CFP · 45-degree field of view · 2048x1536px
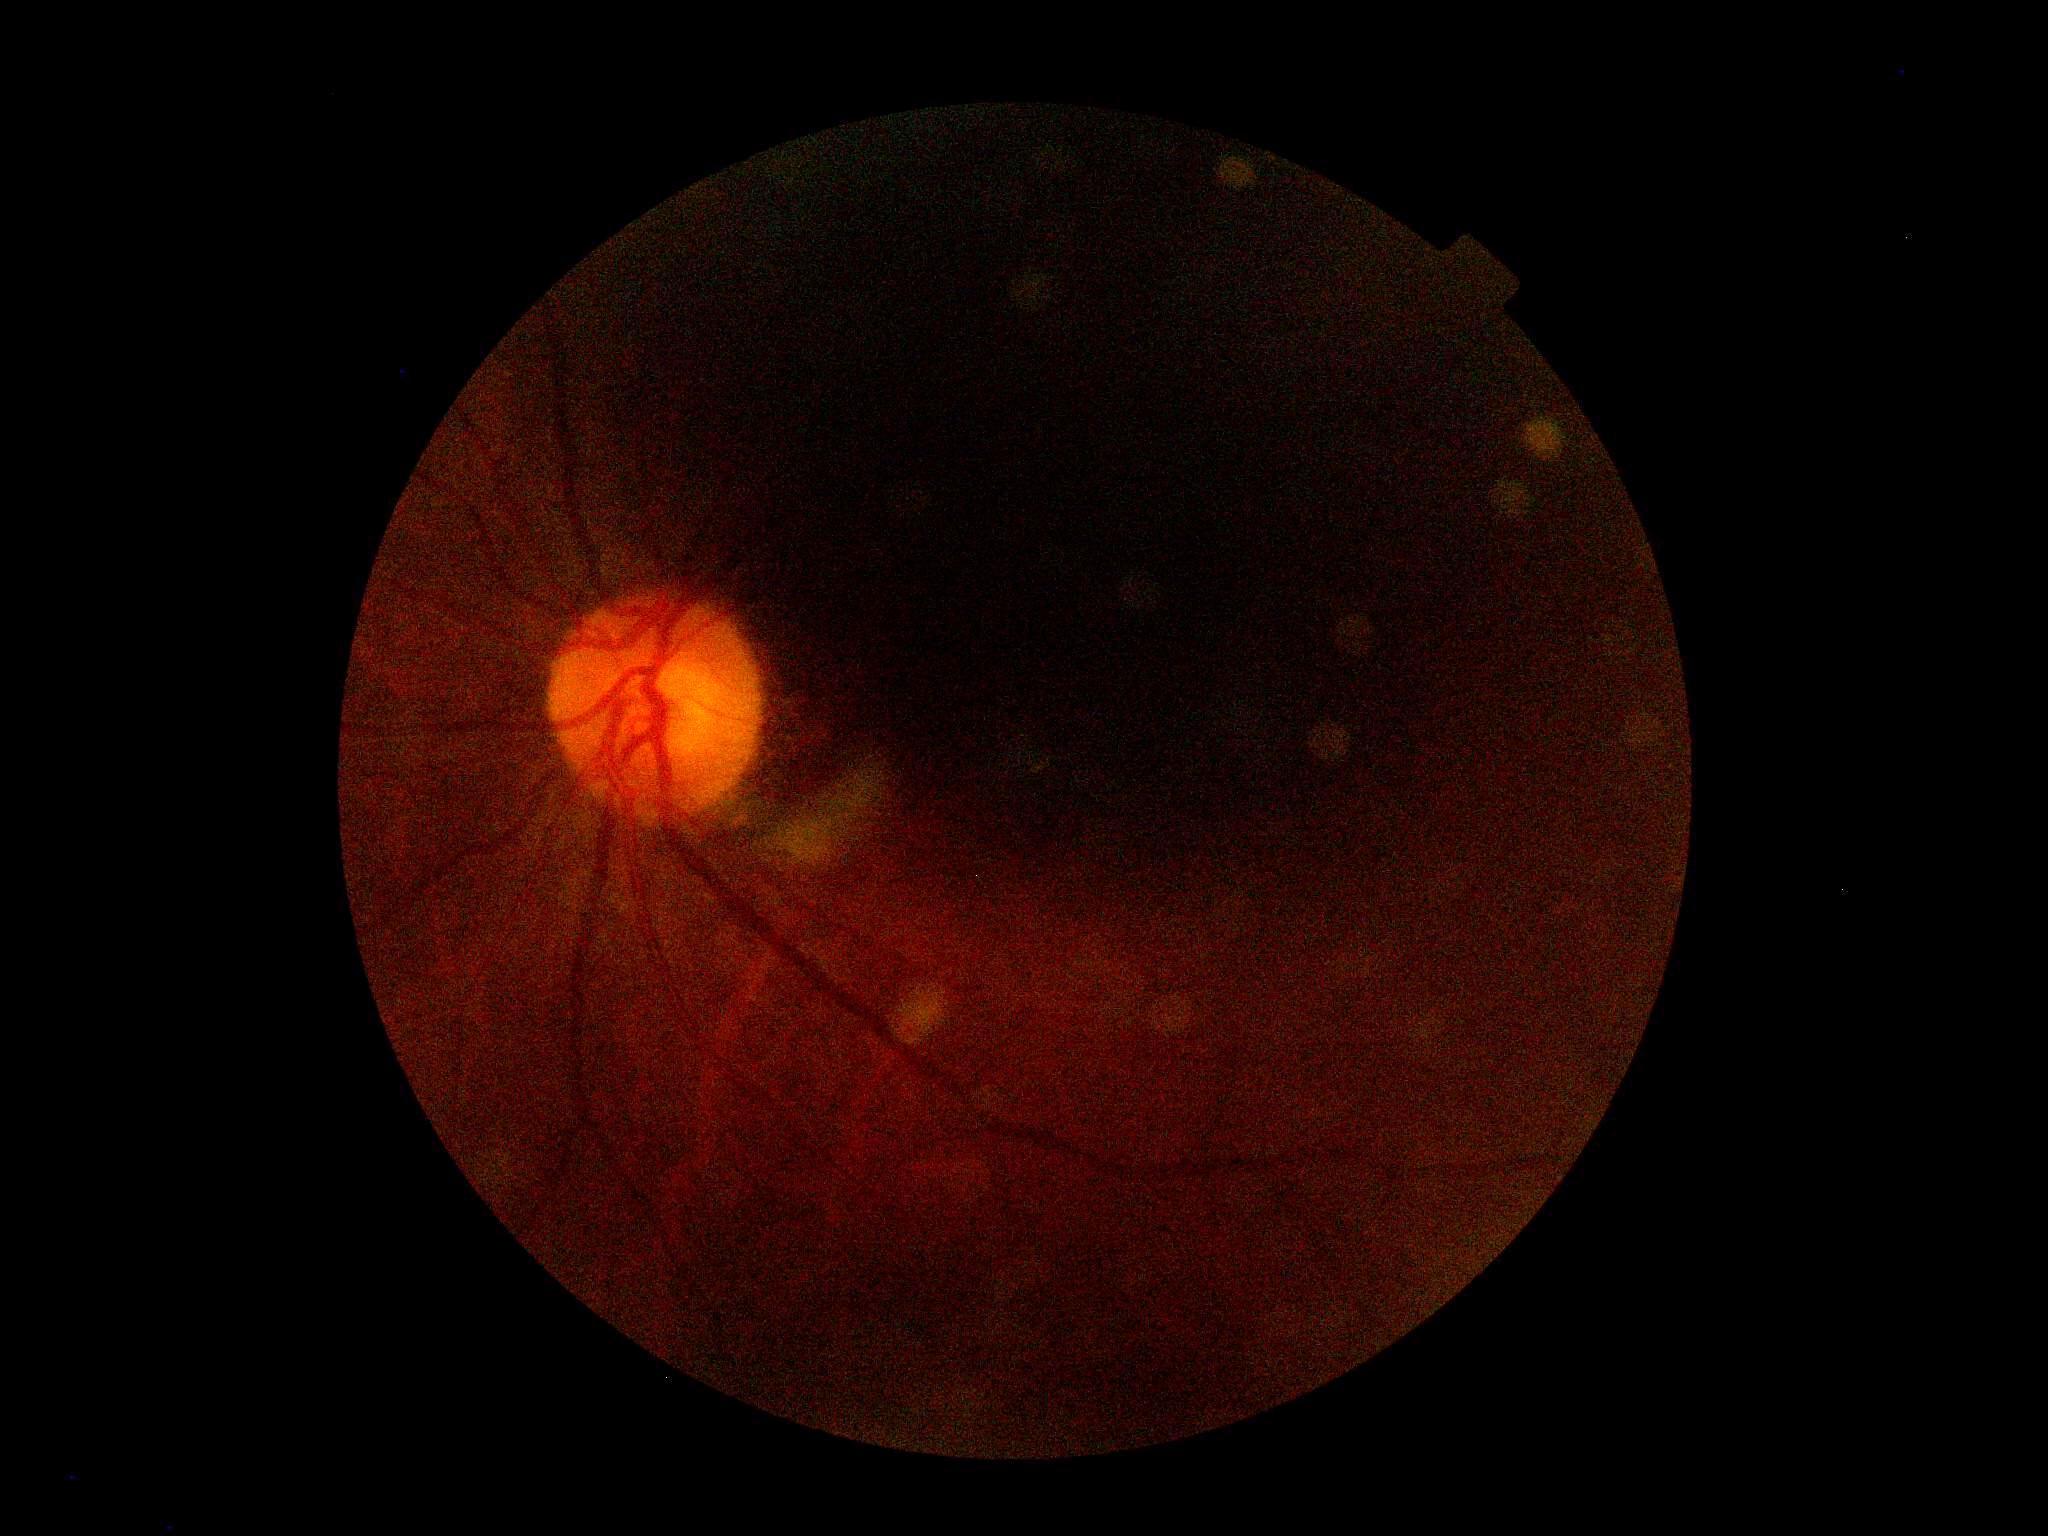
DR grade: ungradable due to poor image quality.
Ungradable image — DR severity cannot be determined.